Fundus image cropped to the optic disc — 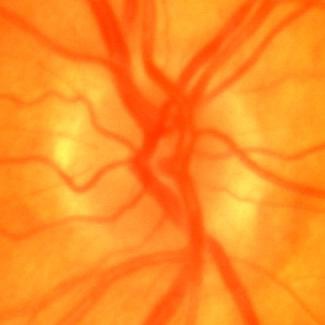

Findings consistent with no signs of glaucoma.